Undilated pupil:
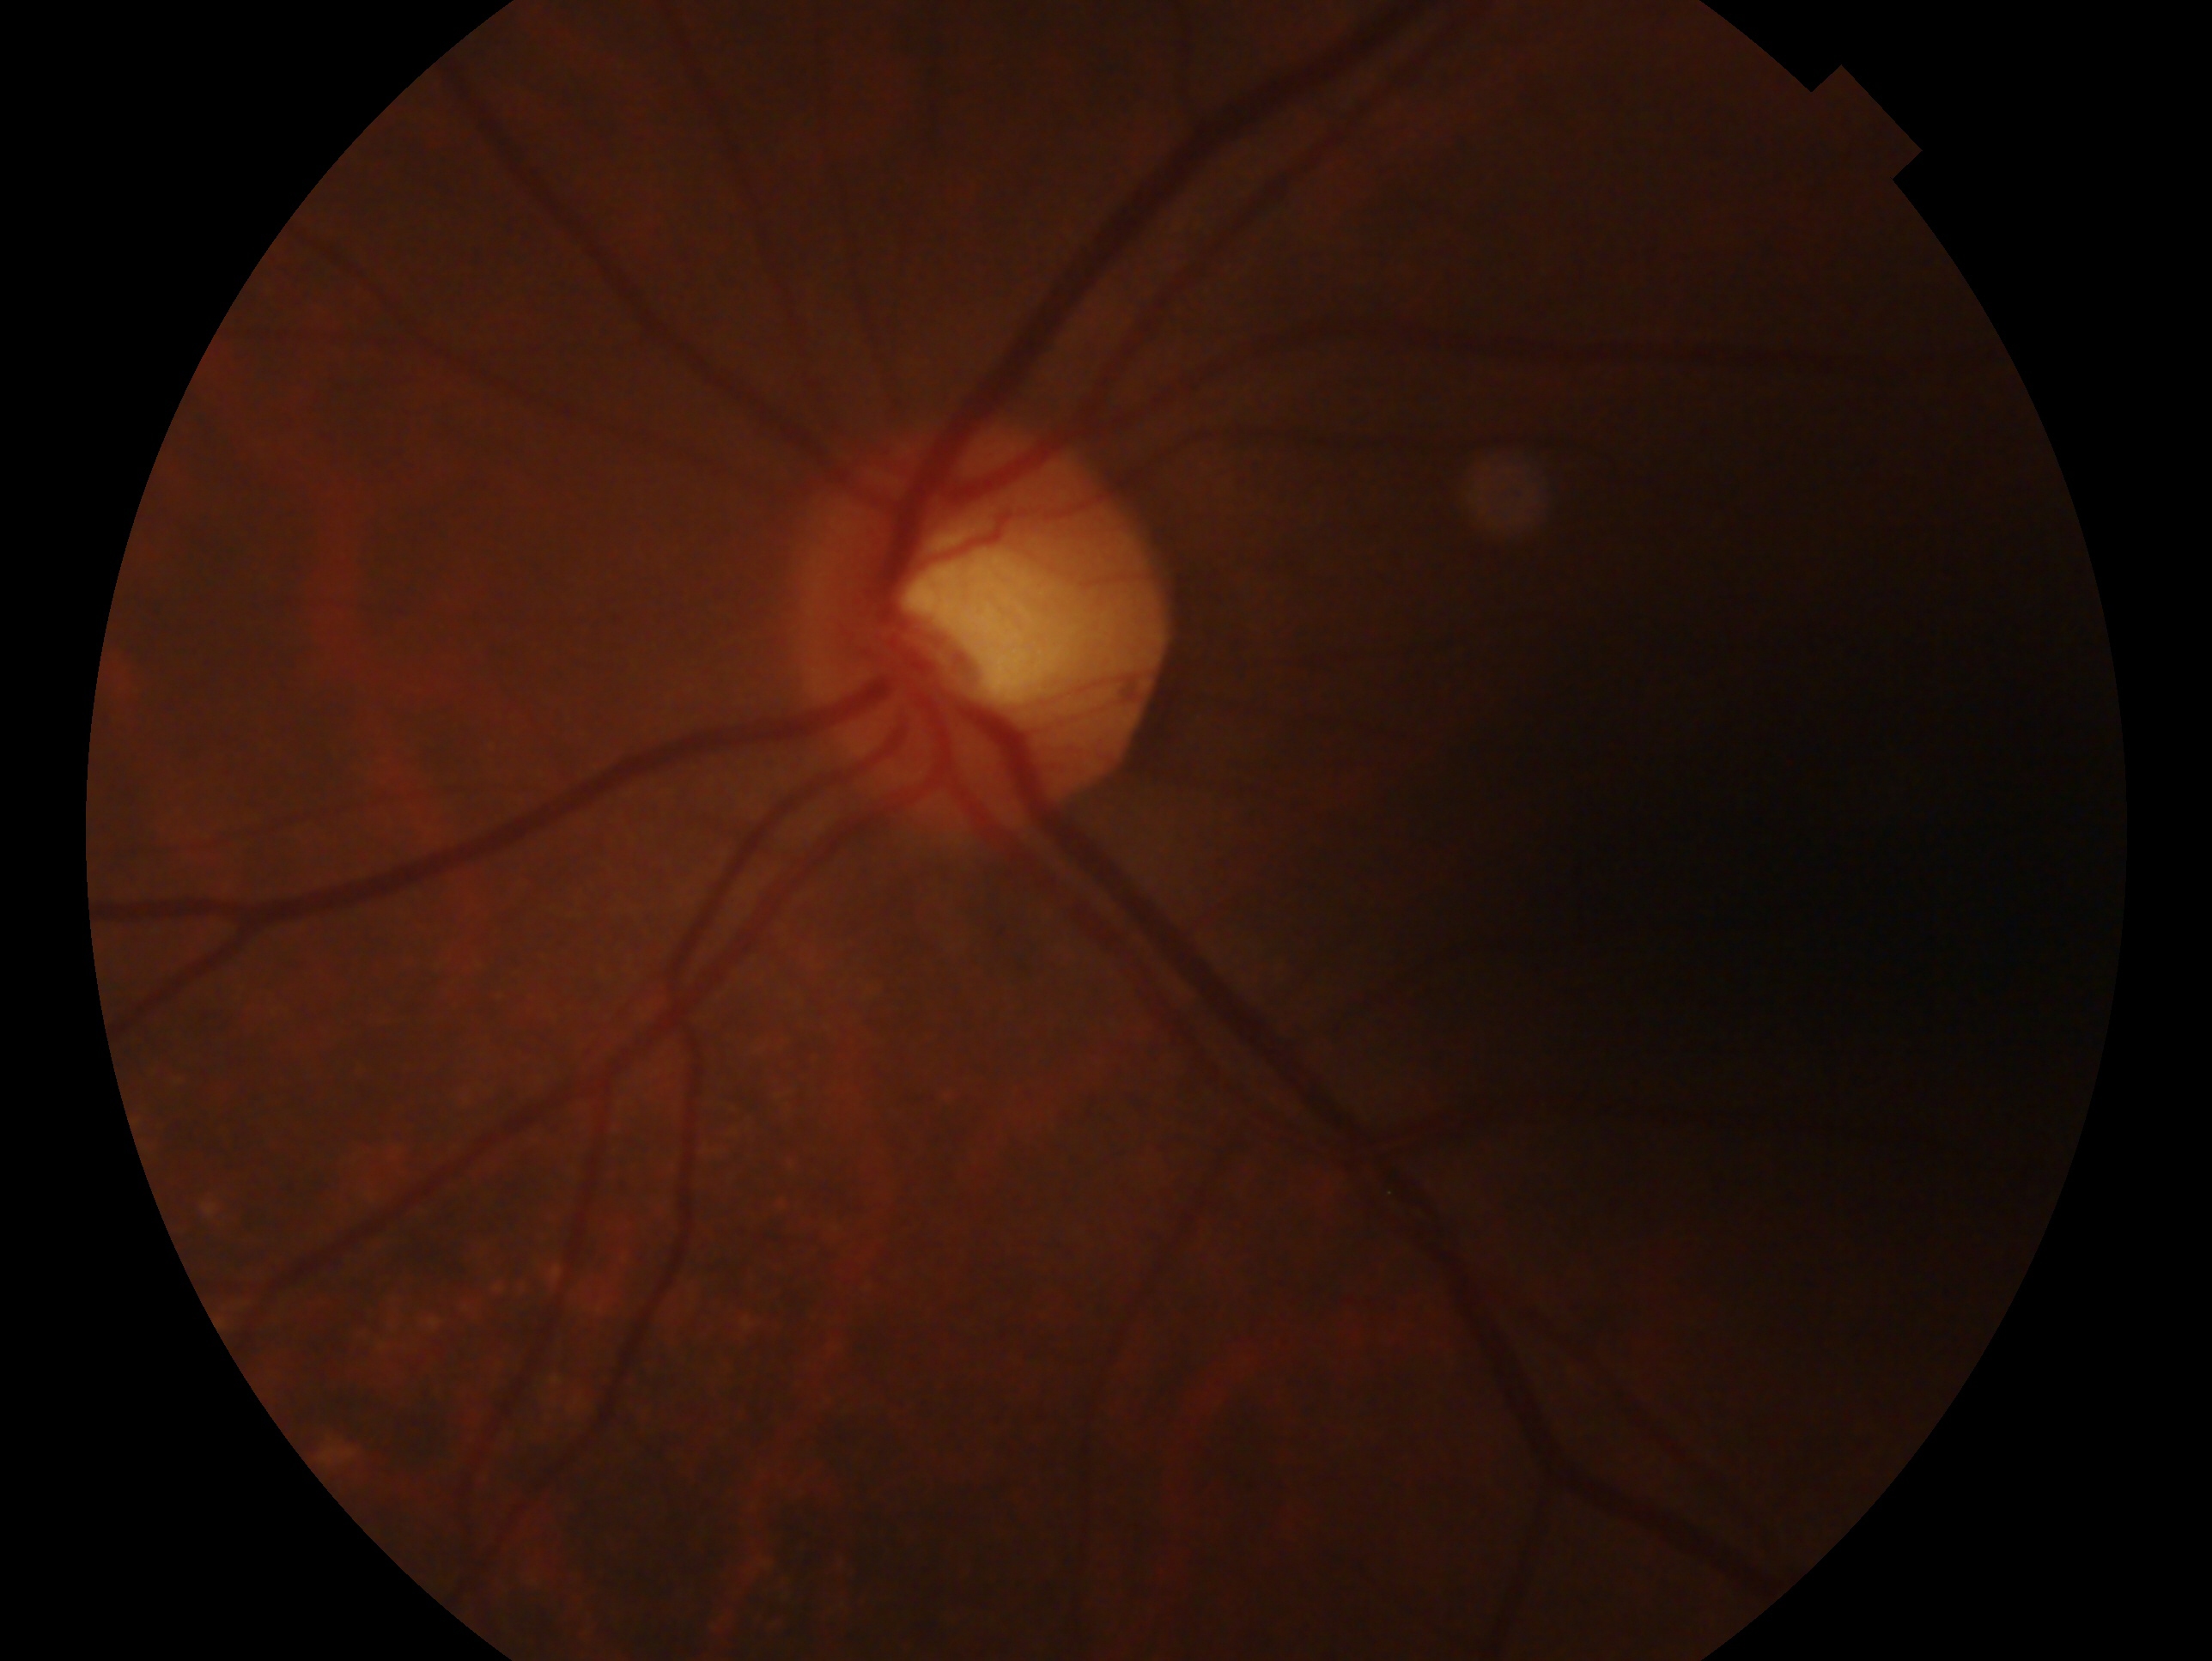 Findings:
• glaucoma assessment · no evidence of glaucoma — no clinical evidence of glaucoma in this eye
• laterality · oculus sinister